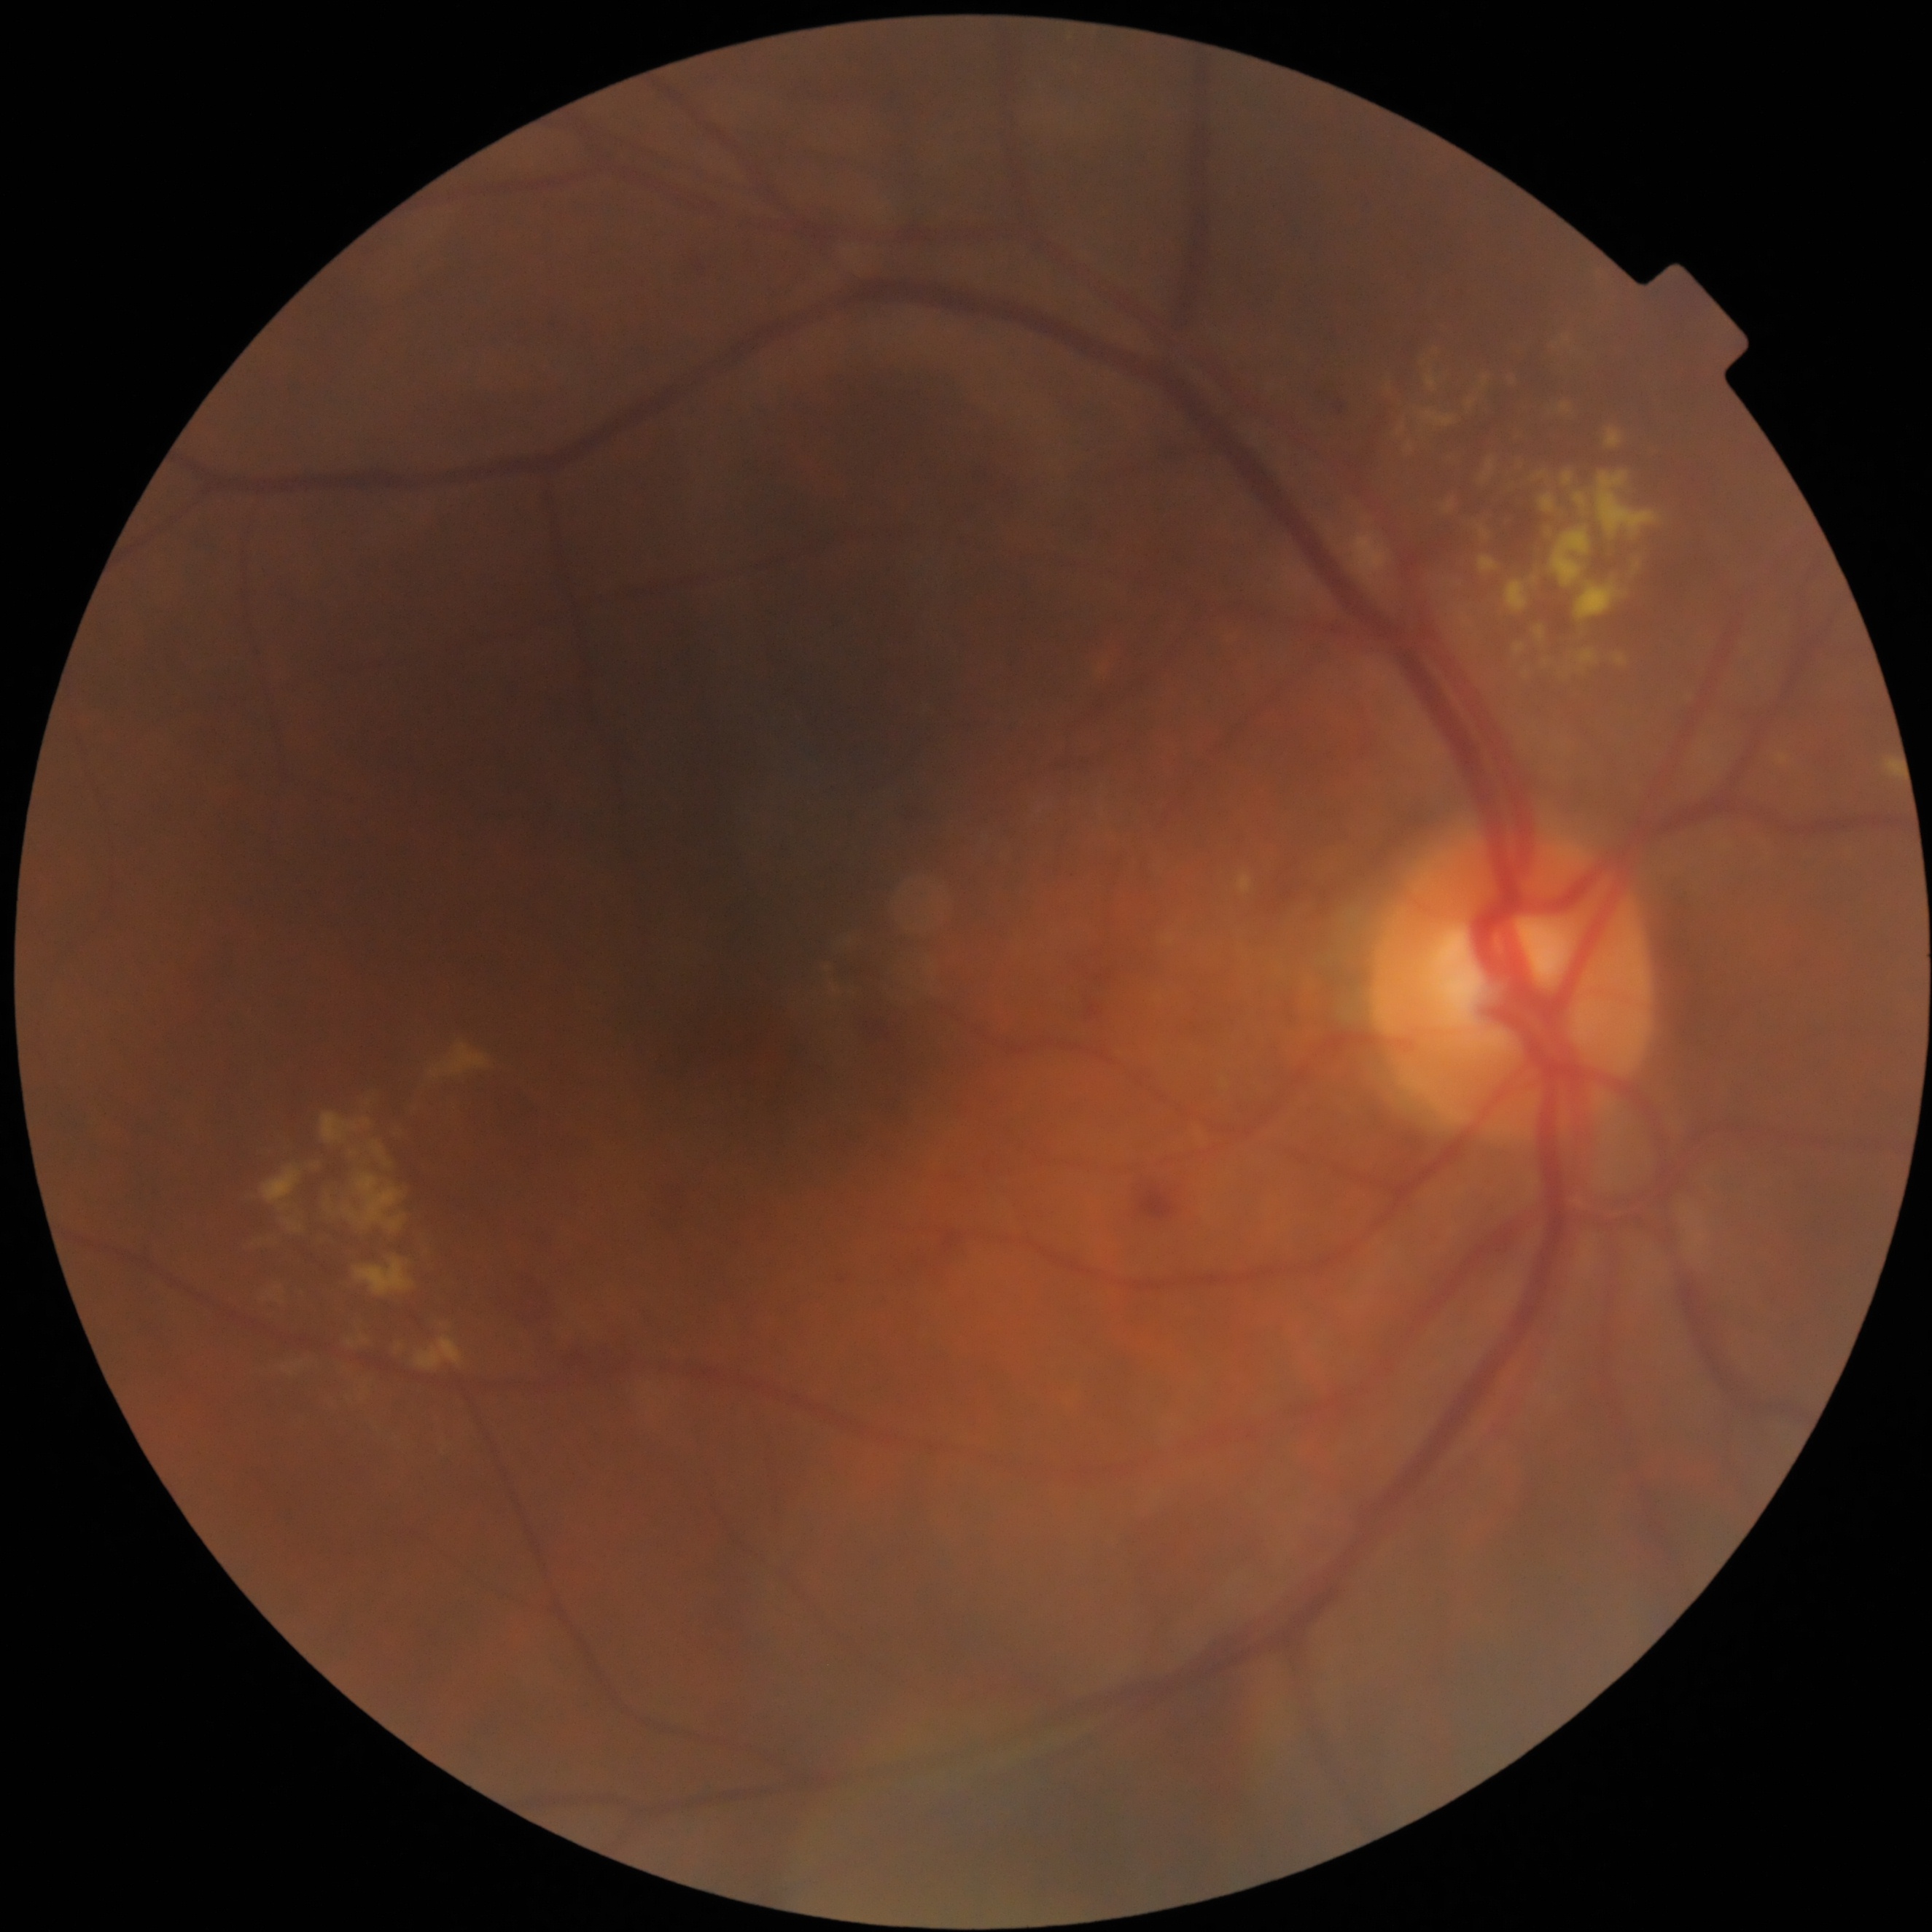 DR stage: grade 2.